Fundus photo
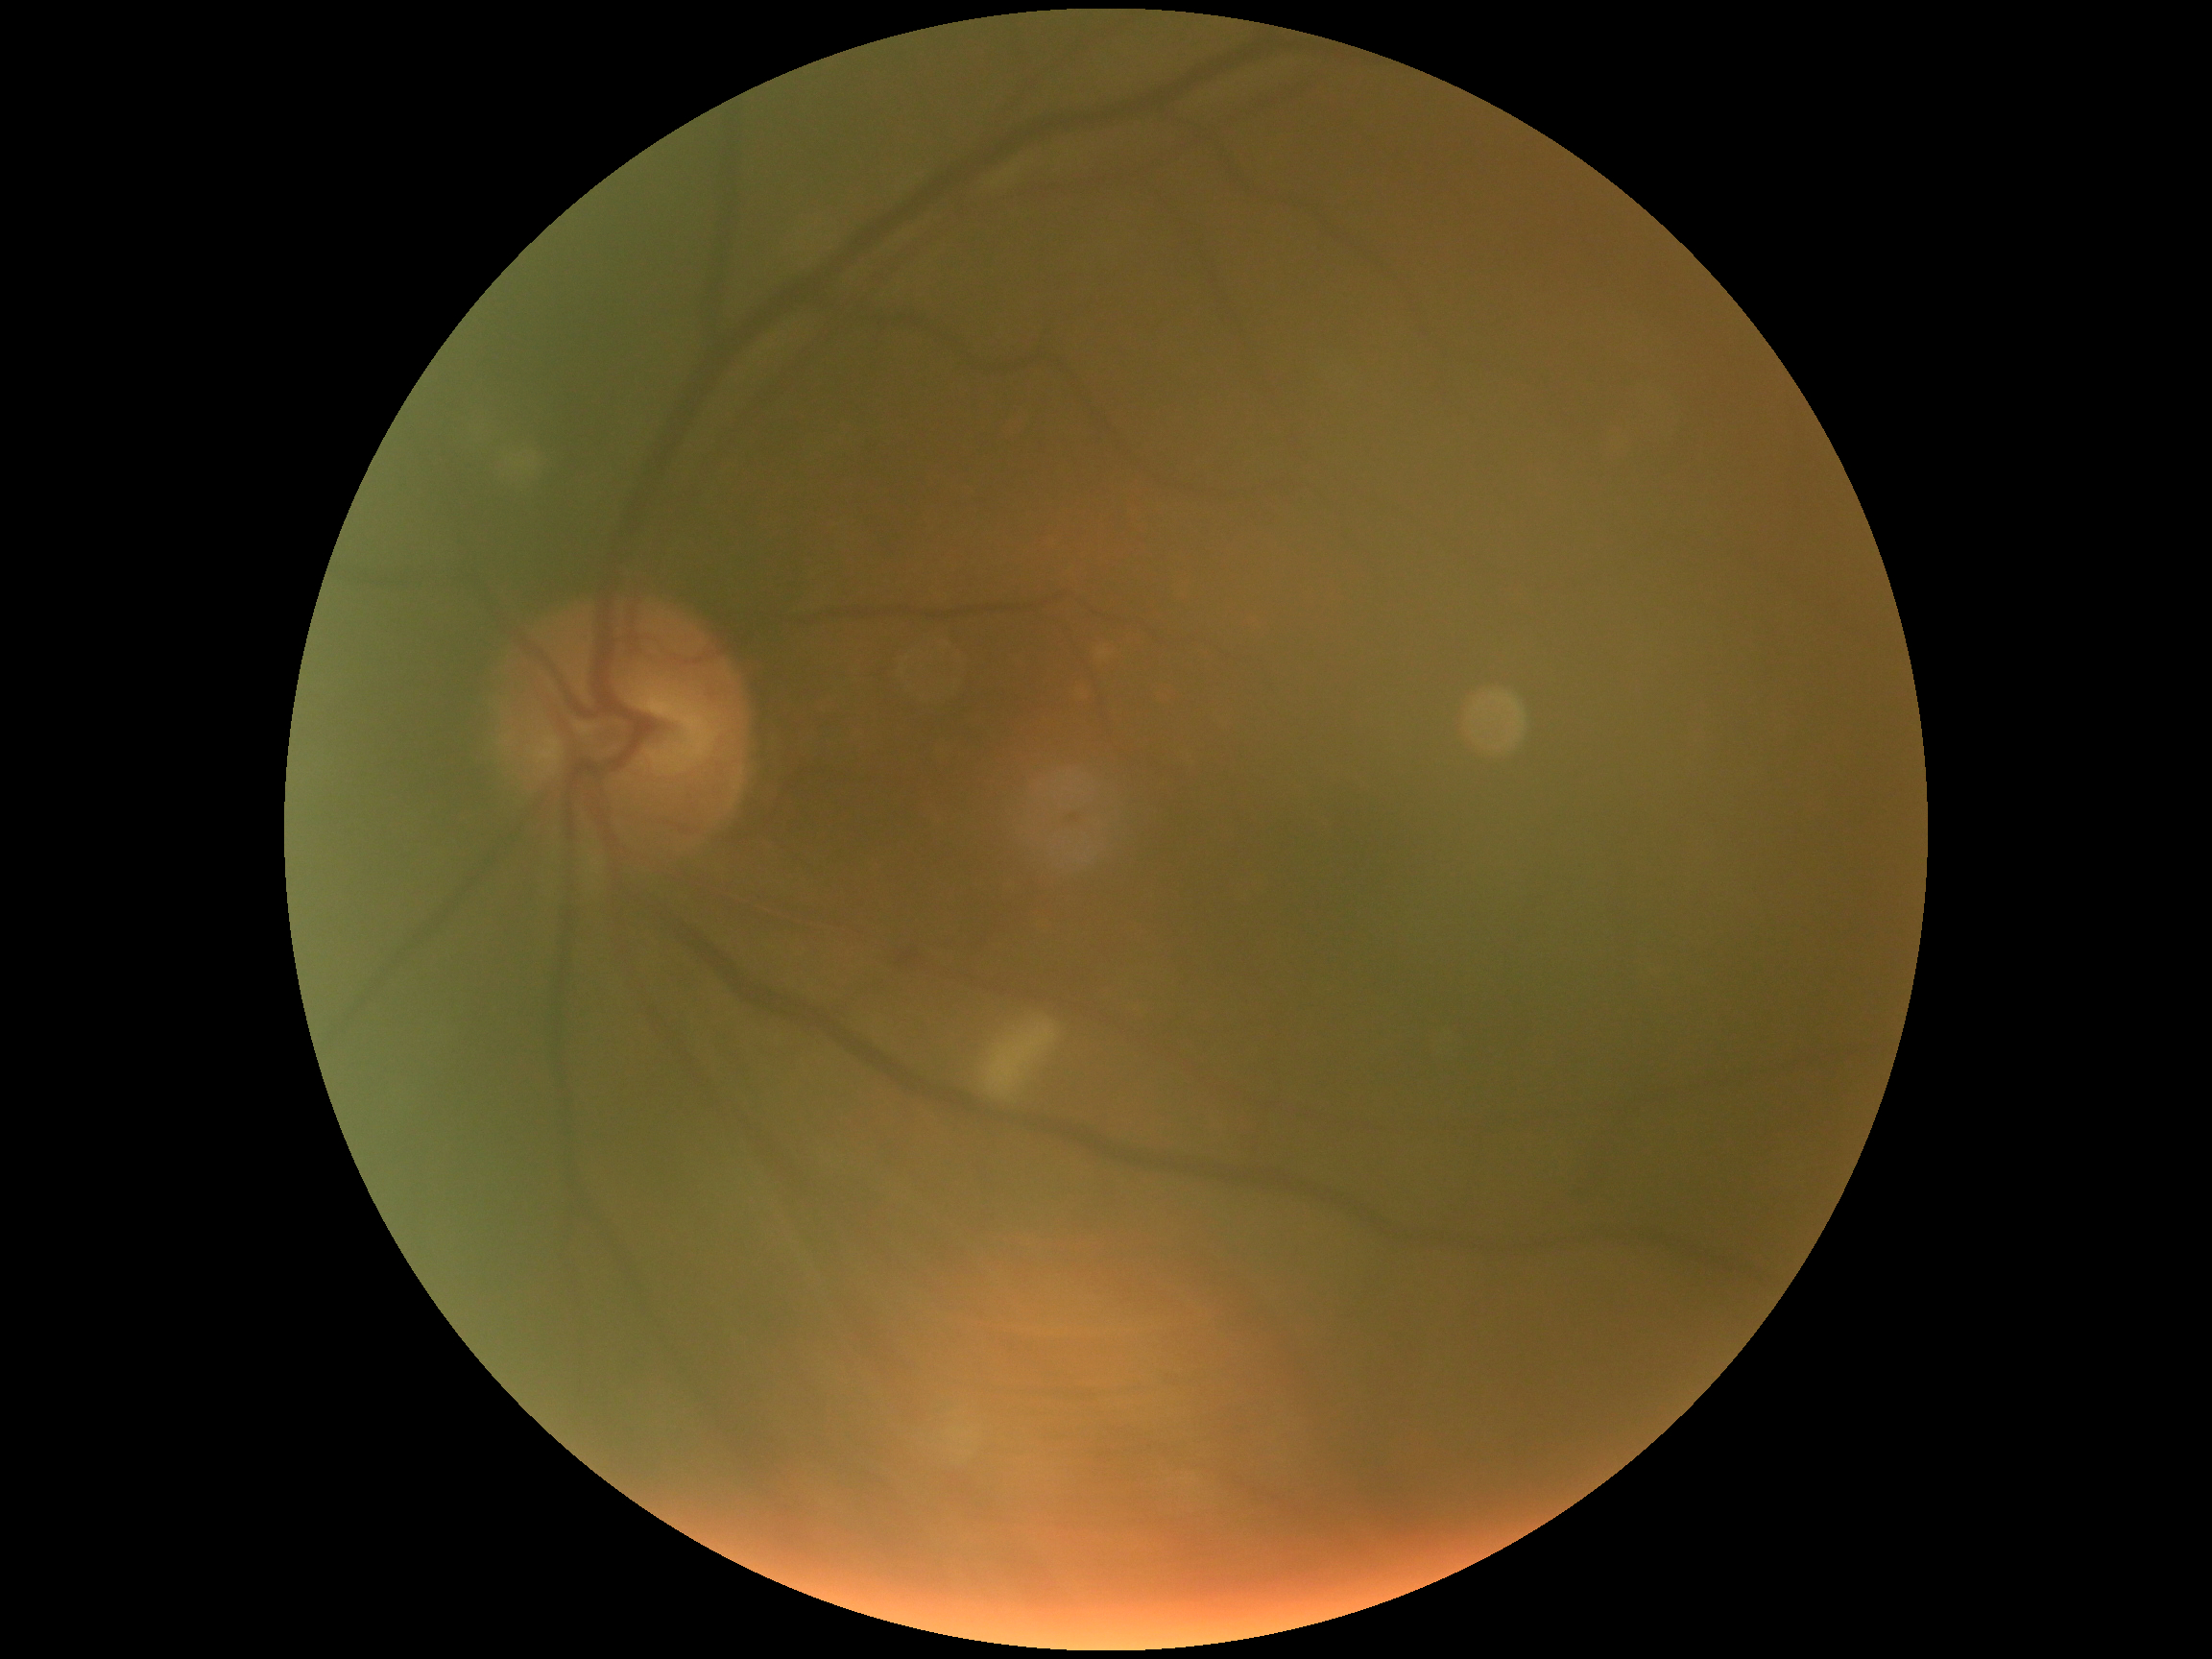

Retinopathy grade: 2 (moderate NPDR).